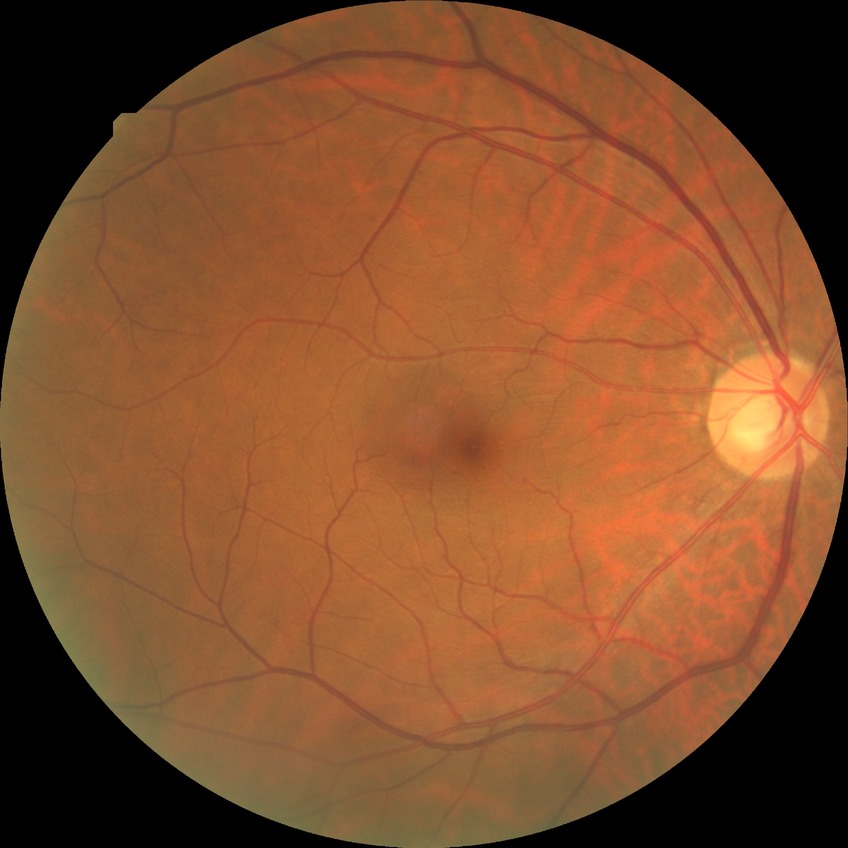
Diabetic retinopathy (DR): NDR (no diabetic retinopathy).